2352 x 1568 pixels, color fundus photograph, 45° FOV:
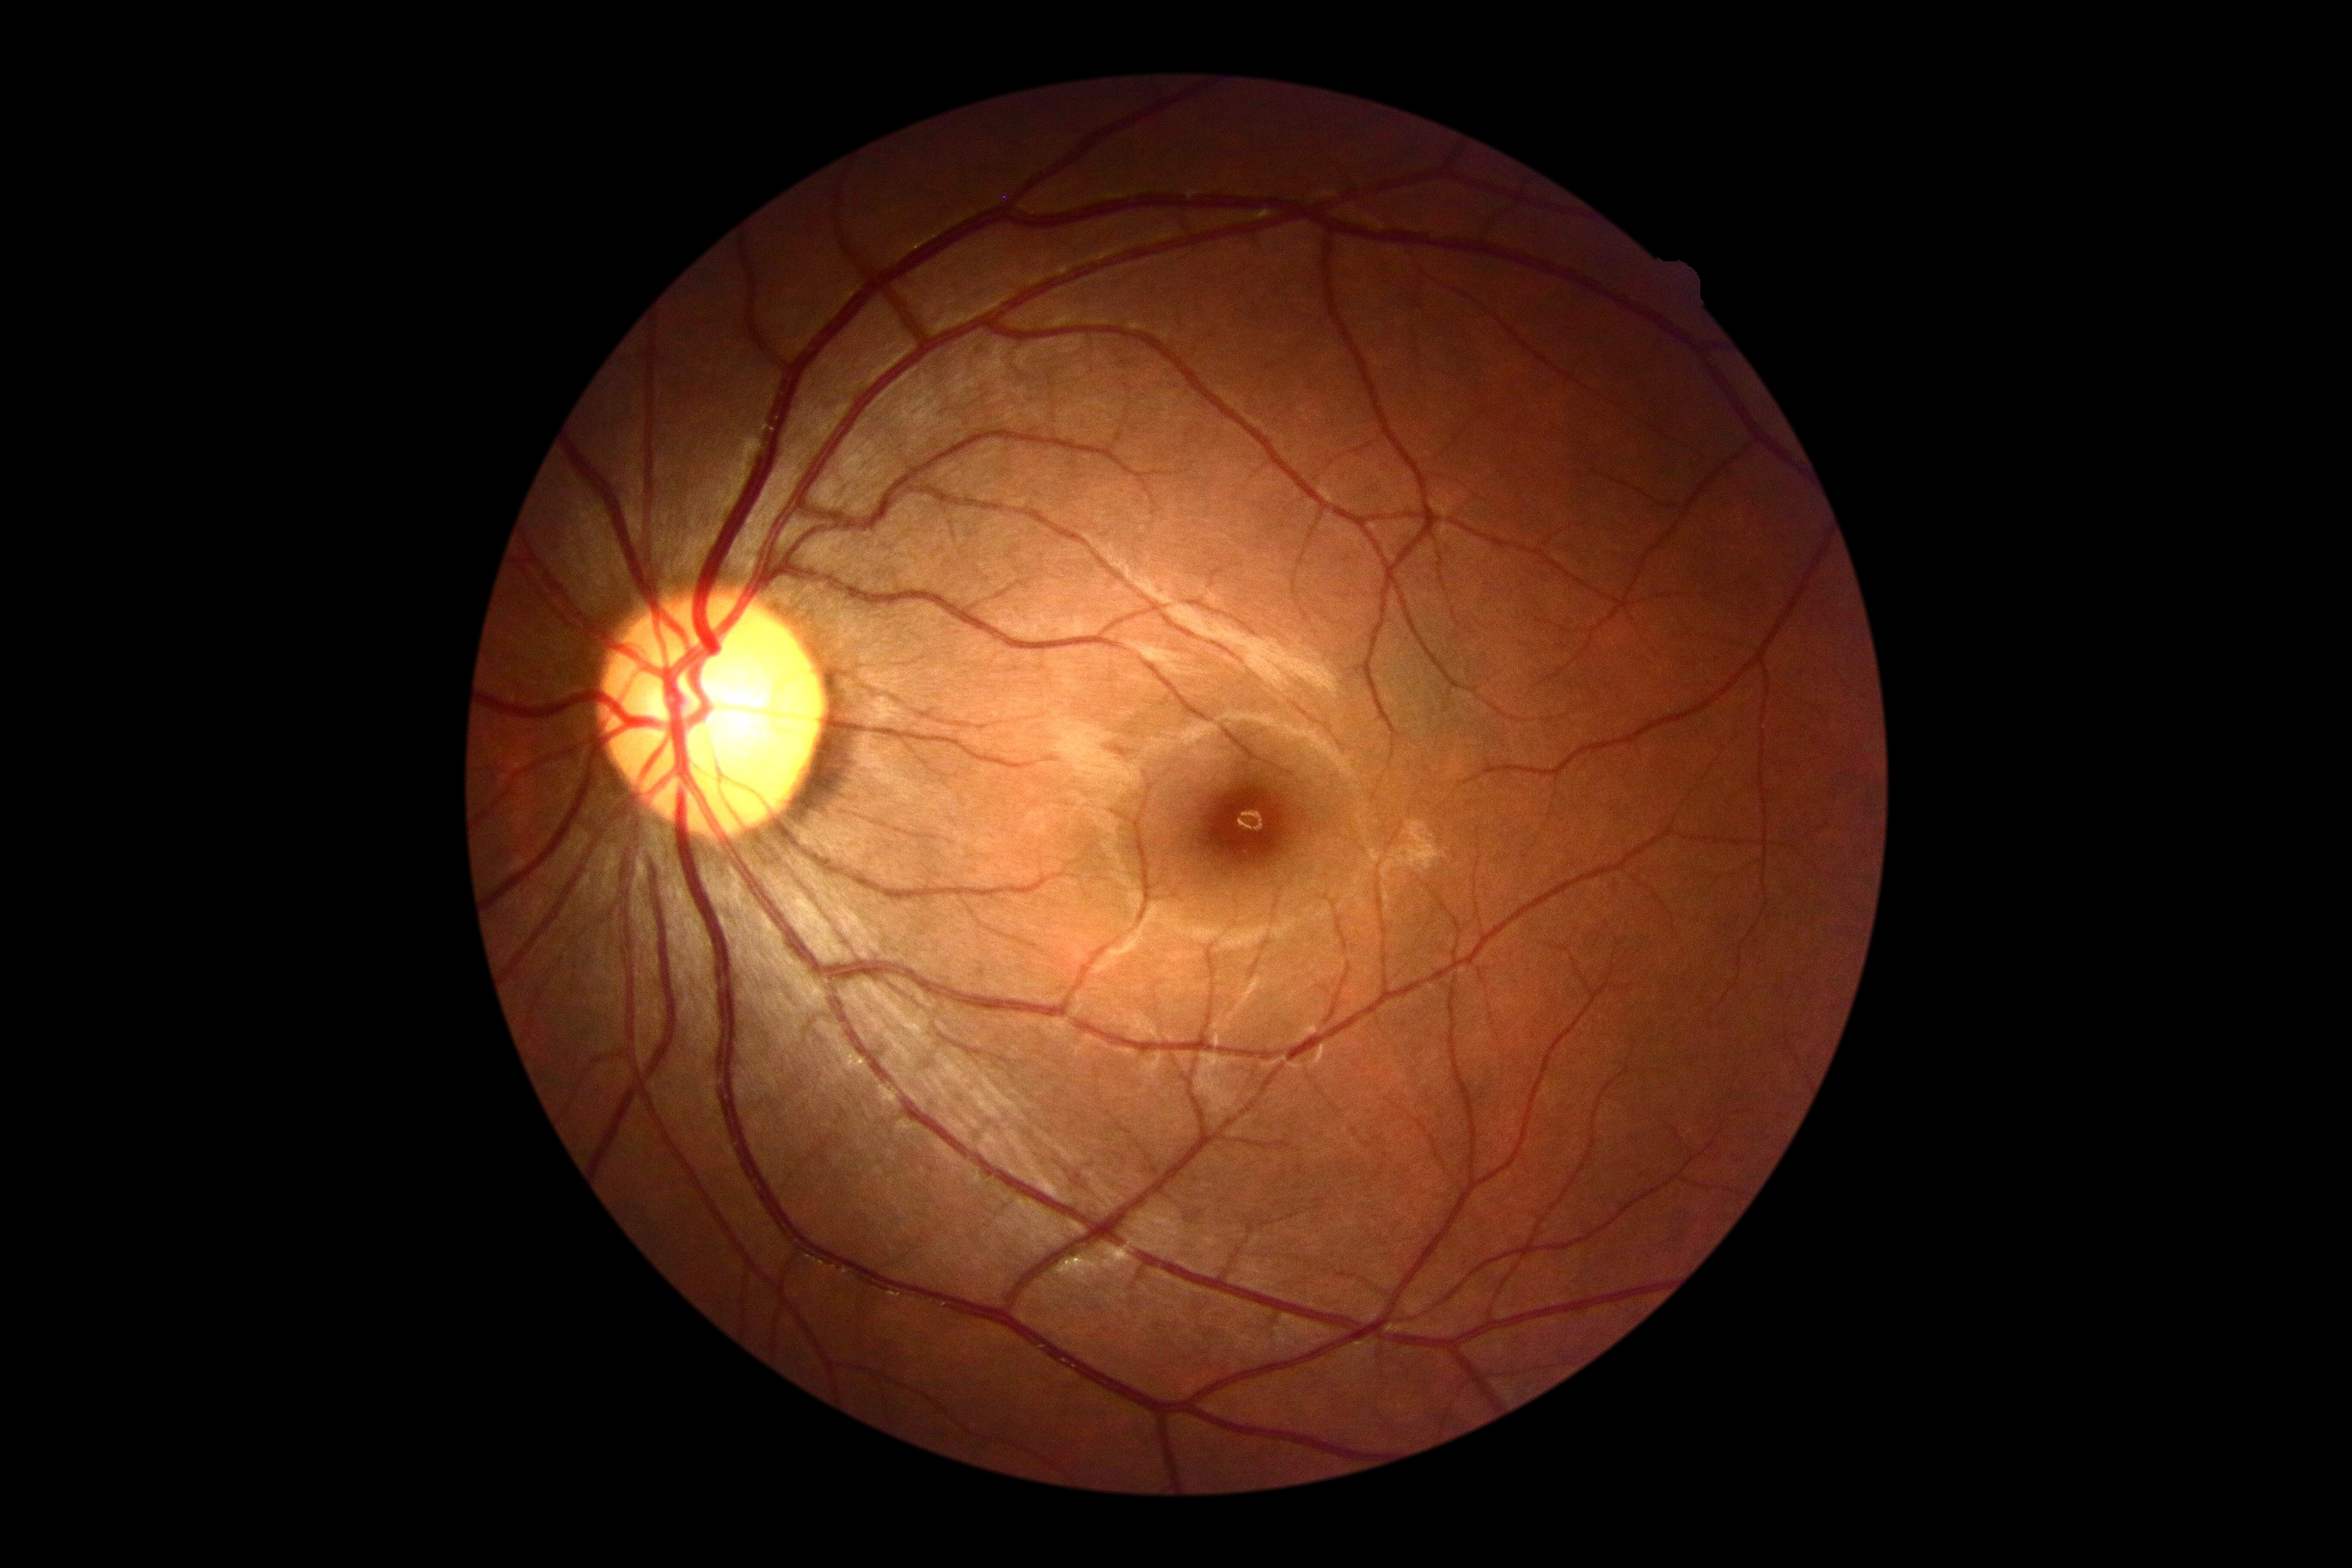

Diabetic retinopathy (DR) is grade 0 (no apparent retinopathy).